Retinal fundus photograph: 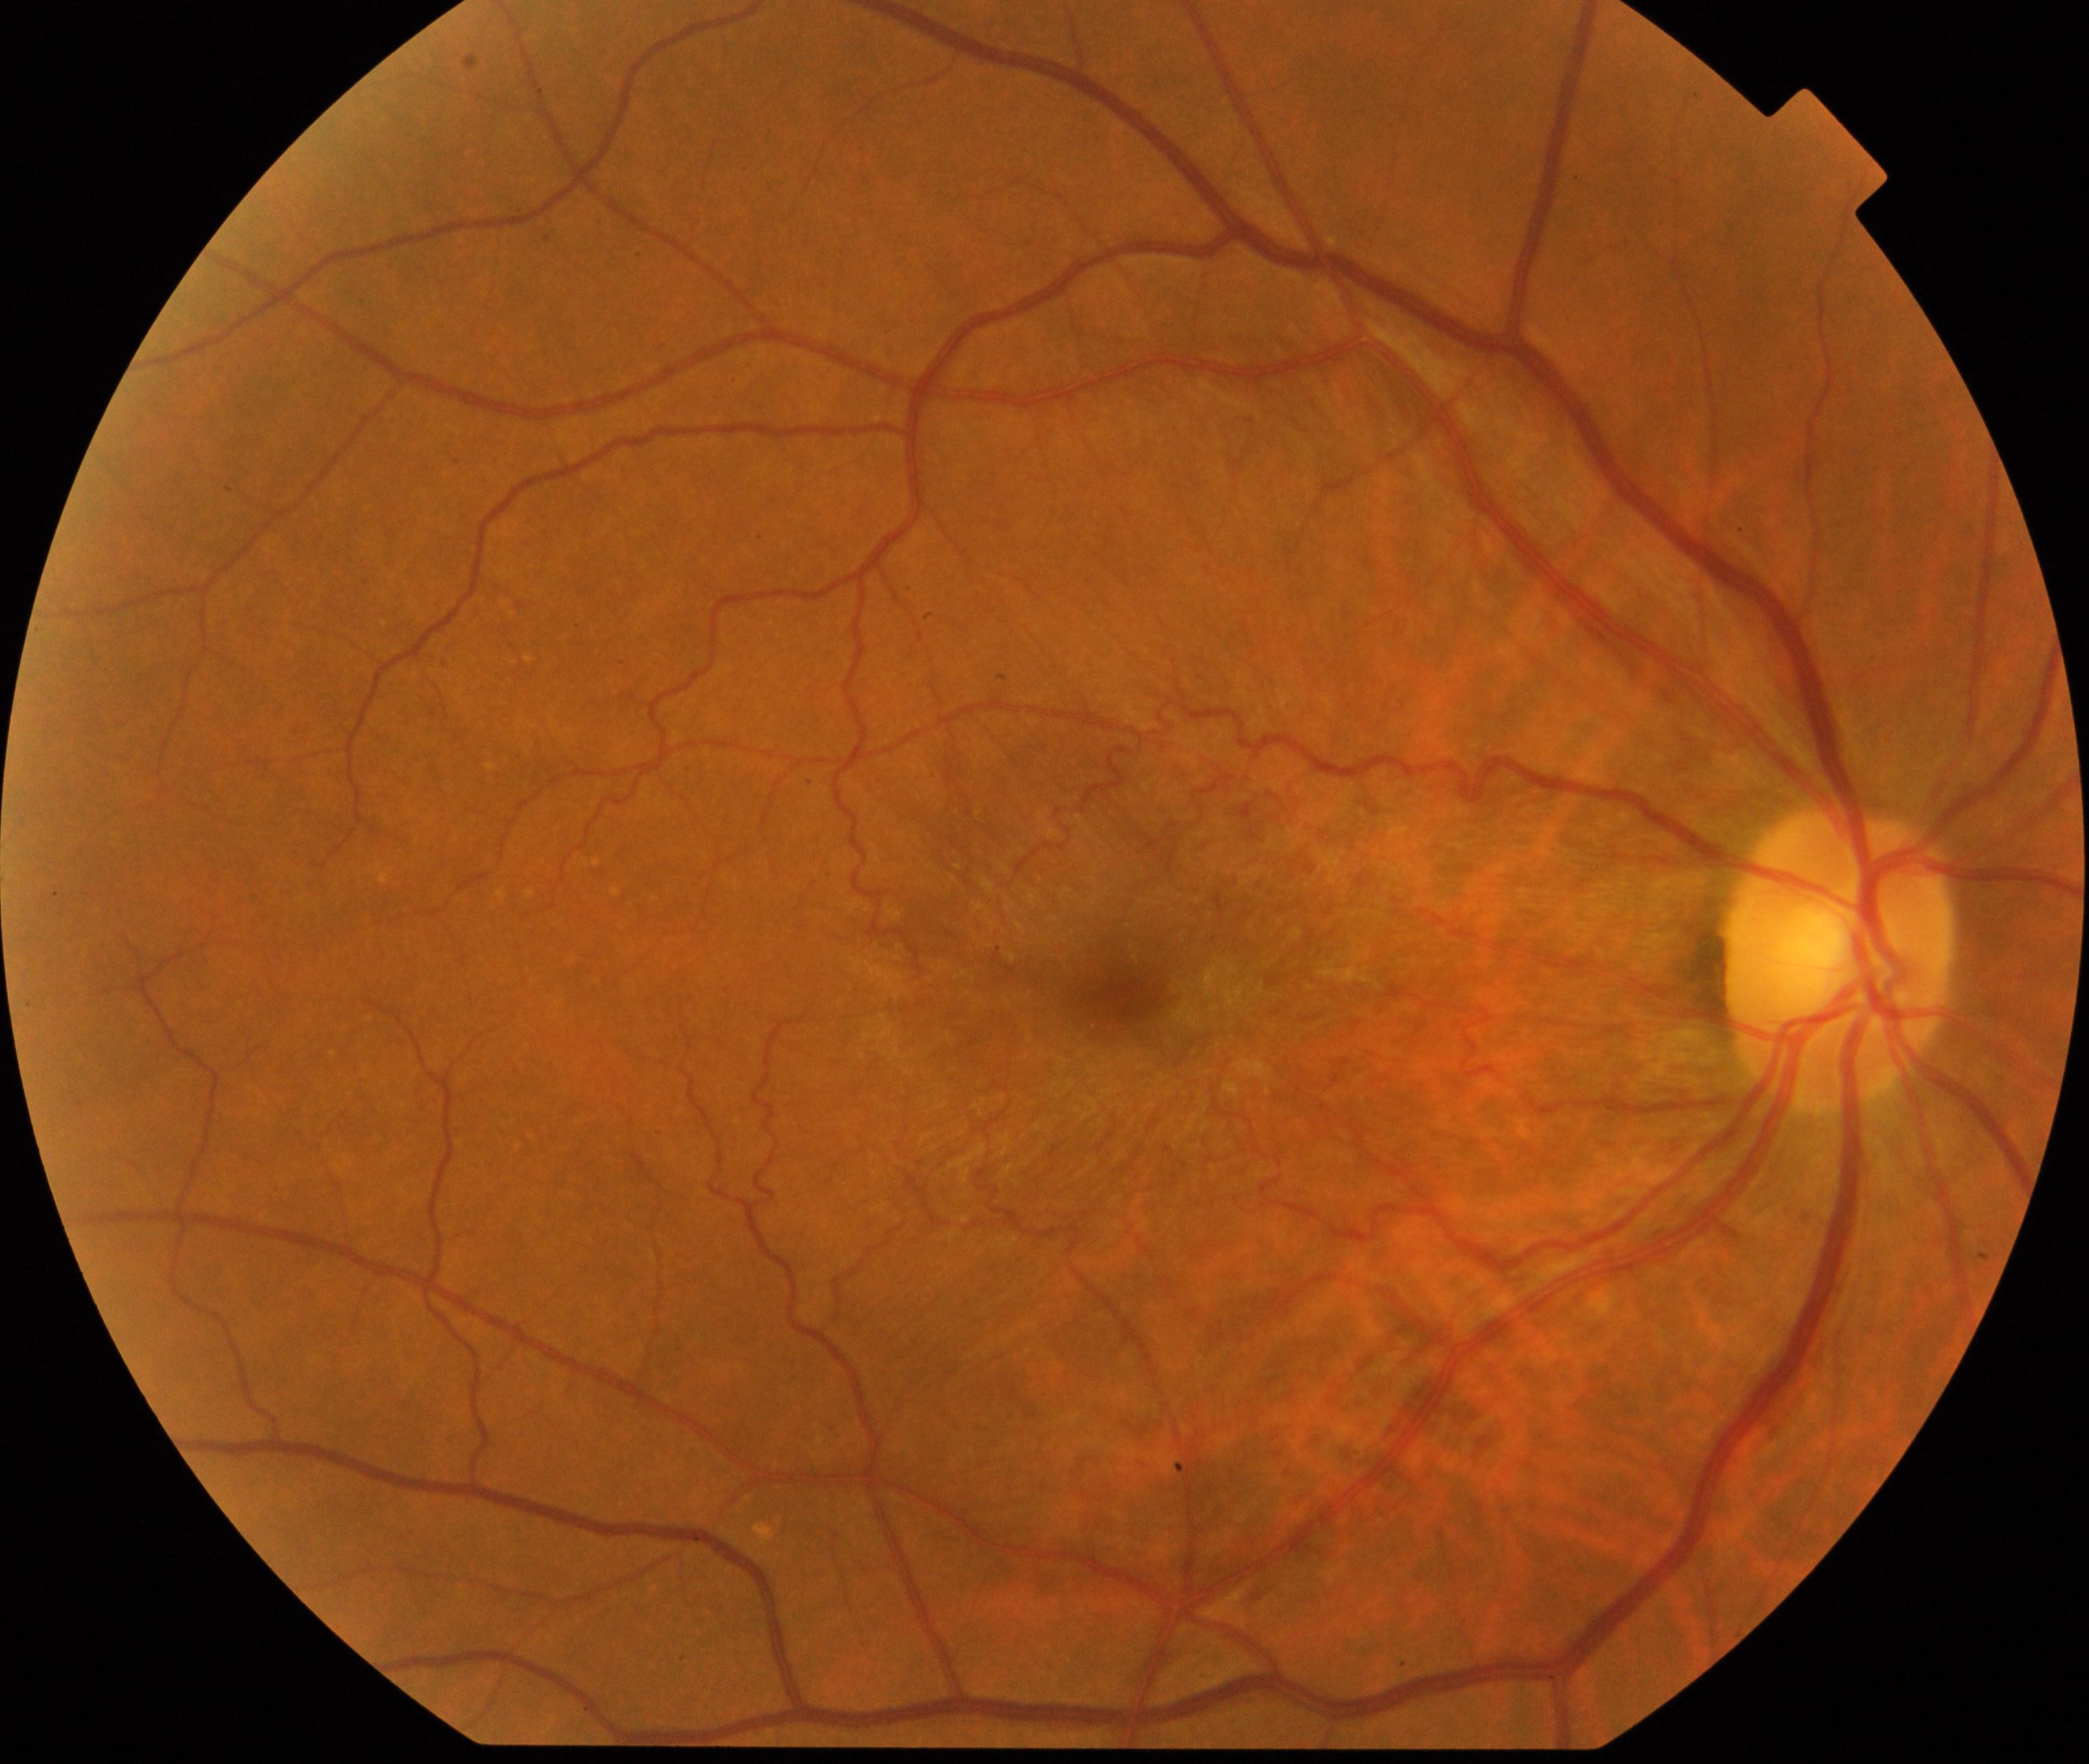

Classification: epiretinal membrane. Typically showing a cellophane-sheen sheet on or above the surface of the retina with macular pucker and distortion of blood vessels within the vessel arcades.